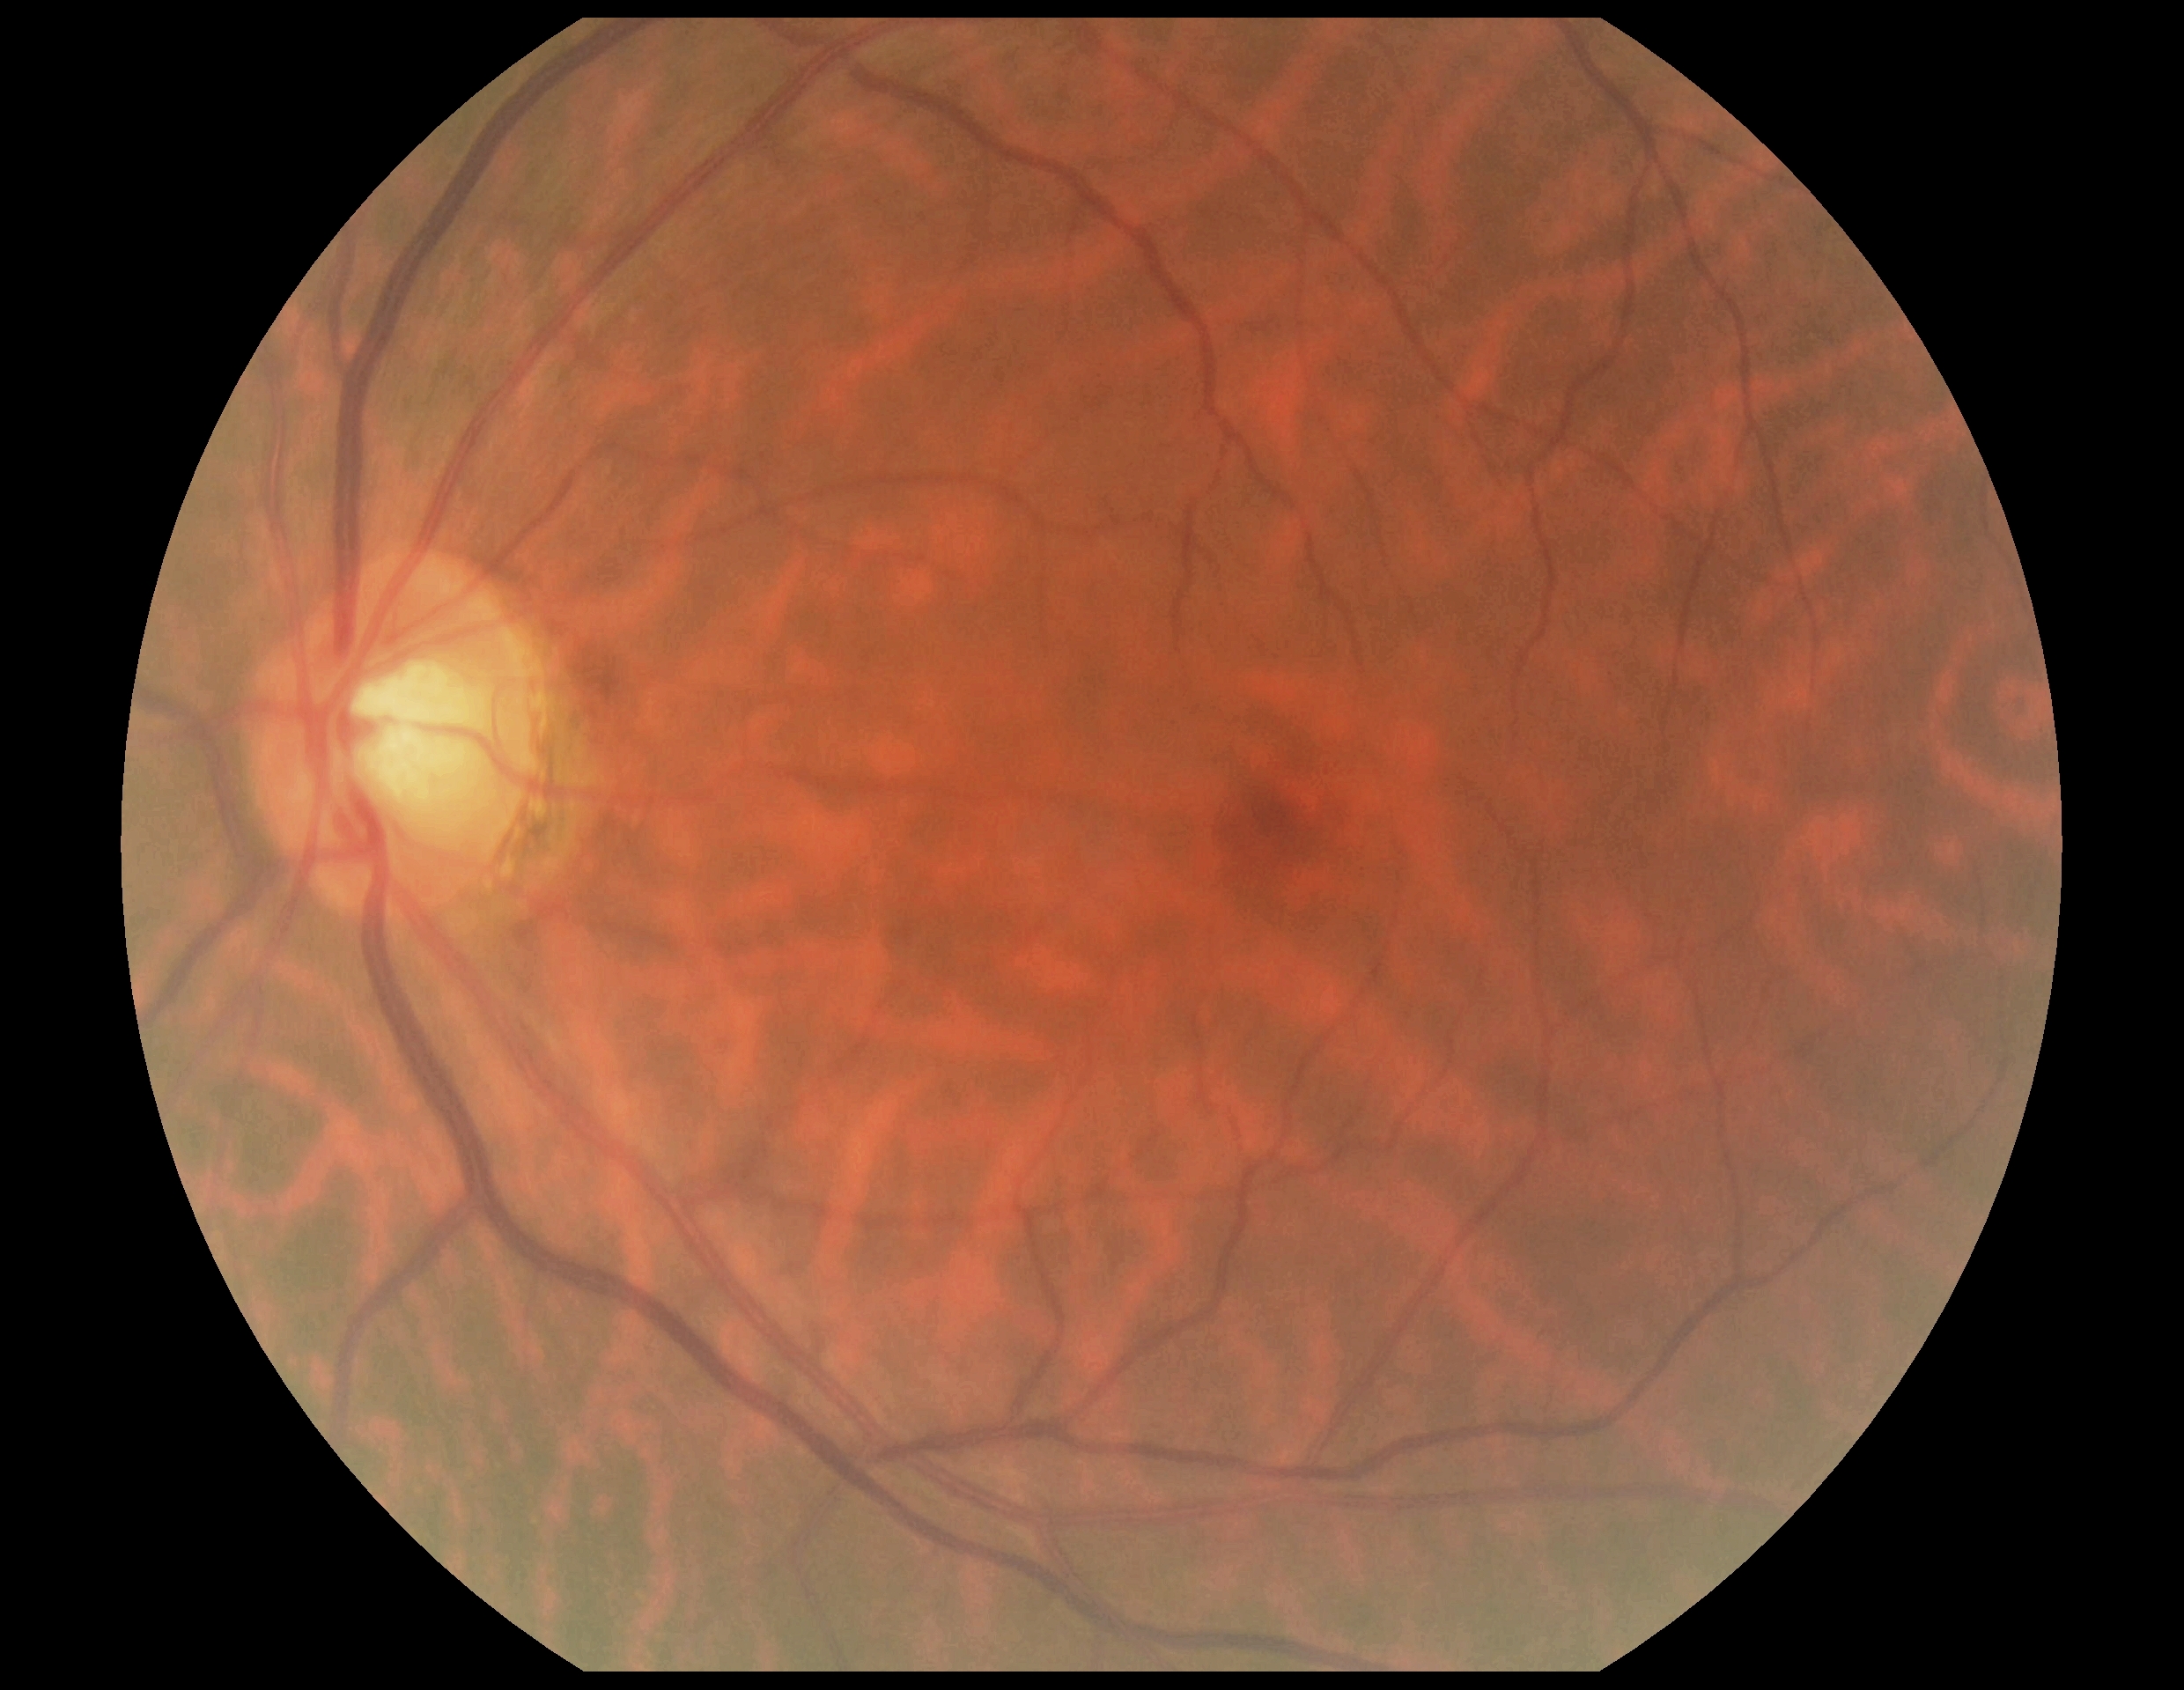
Retinopathy is grade 0.